45° field of view: 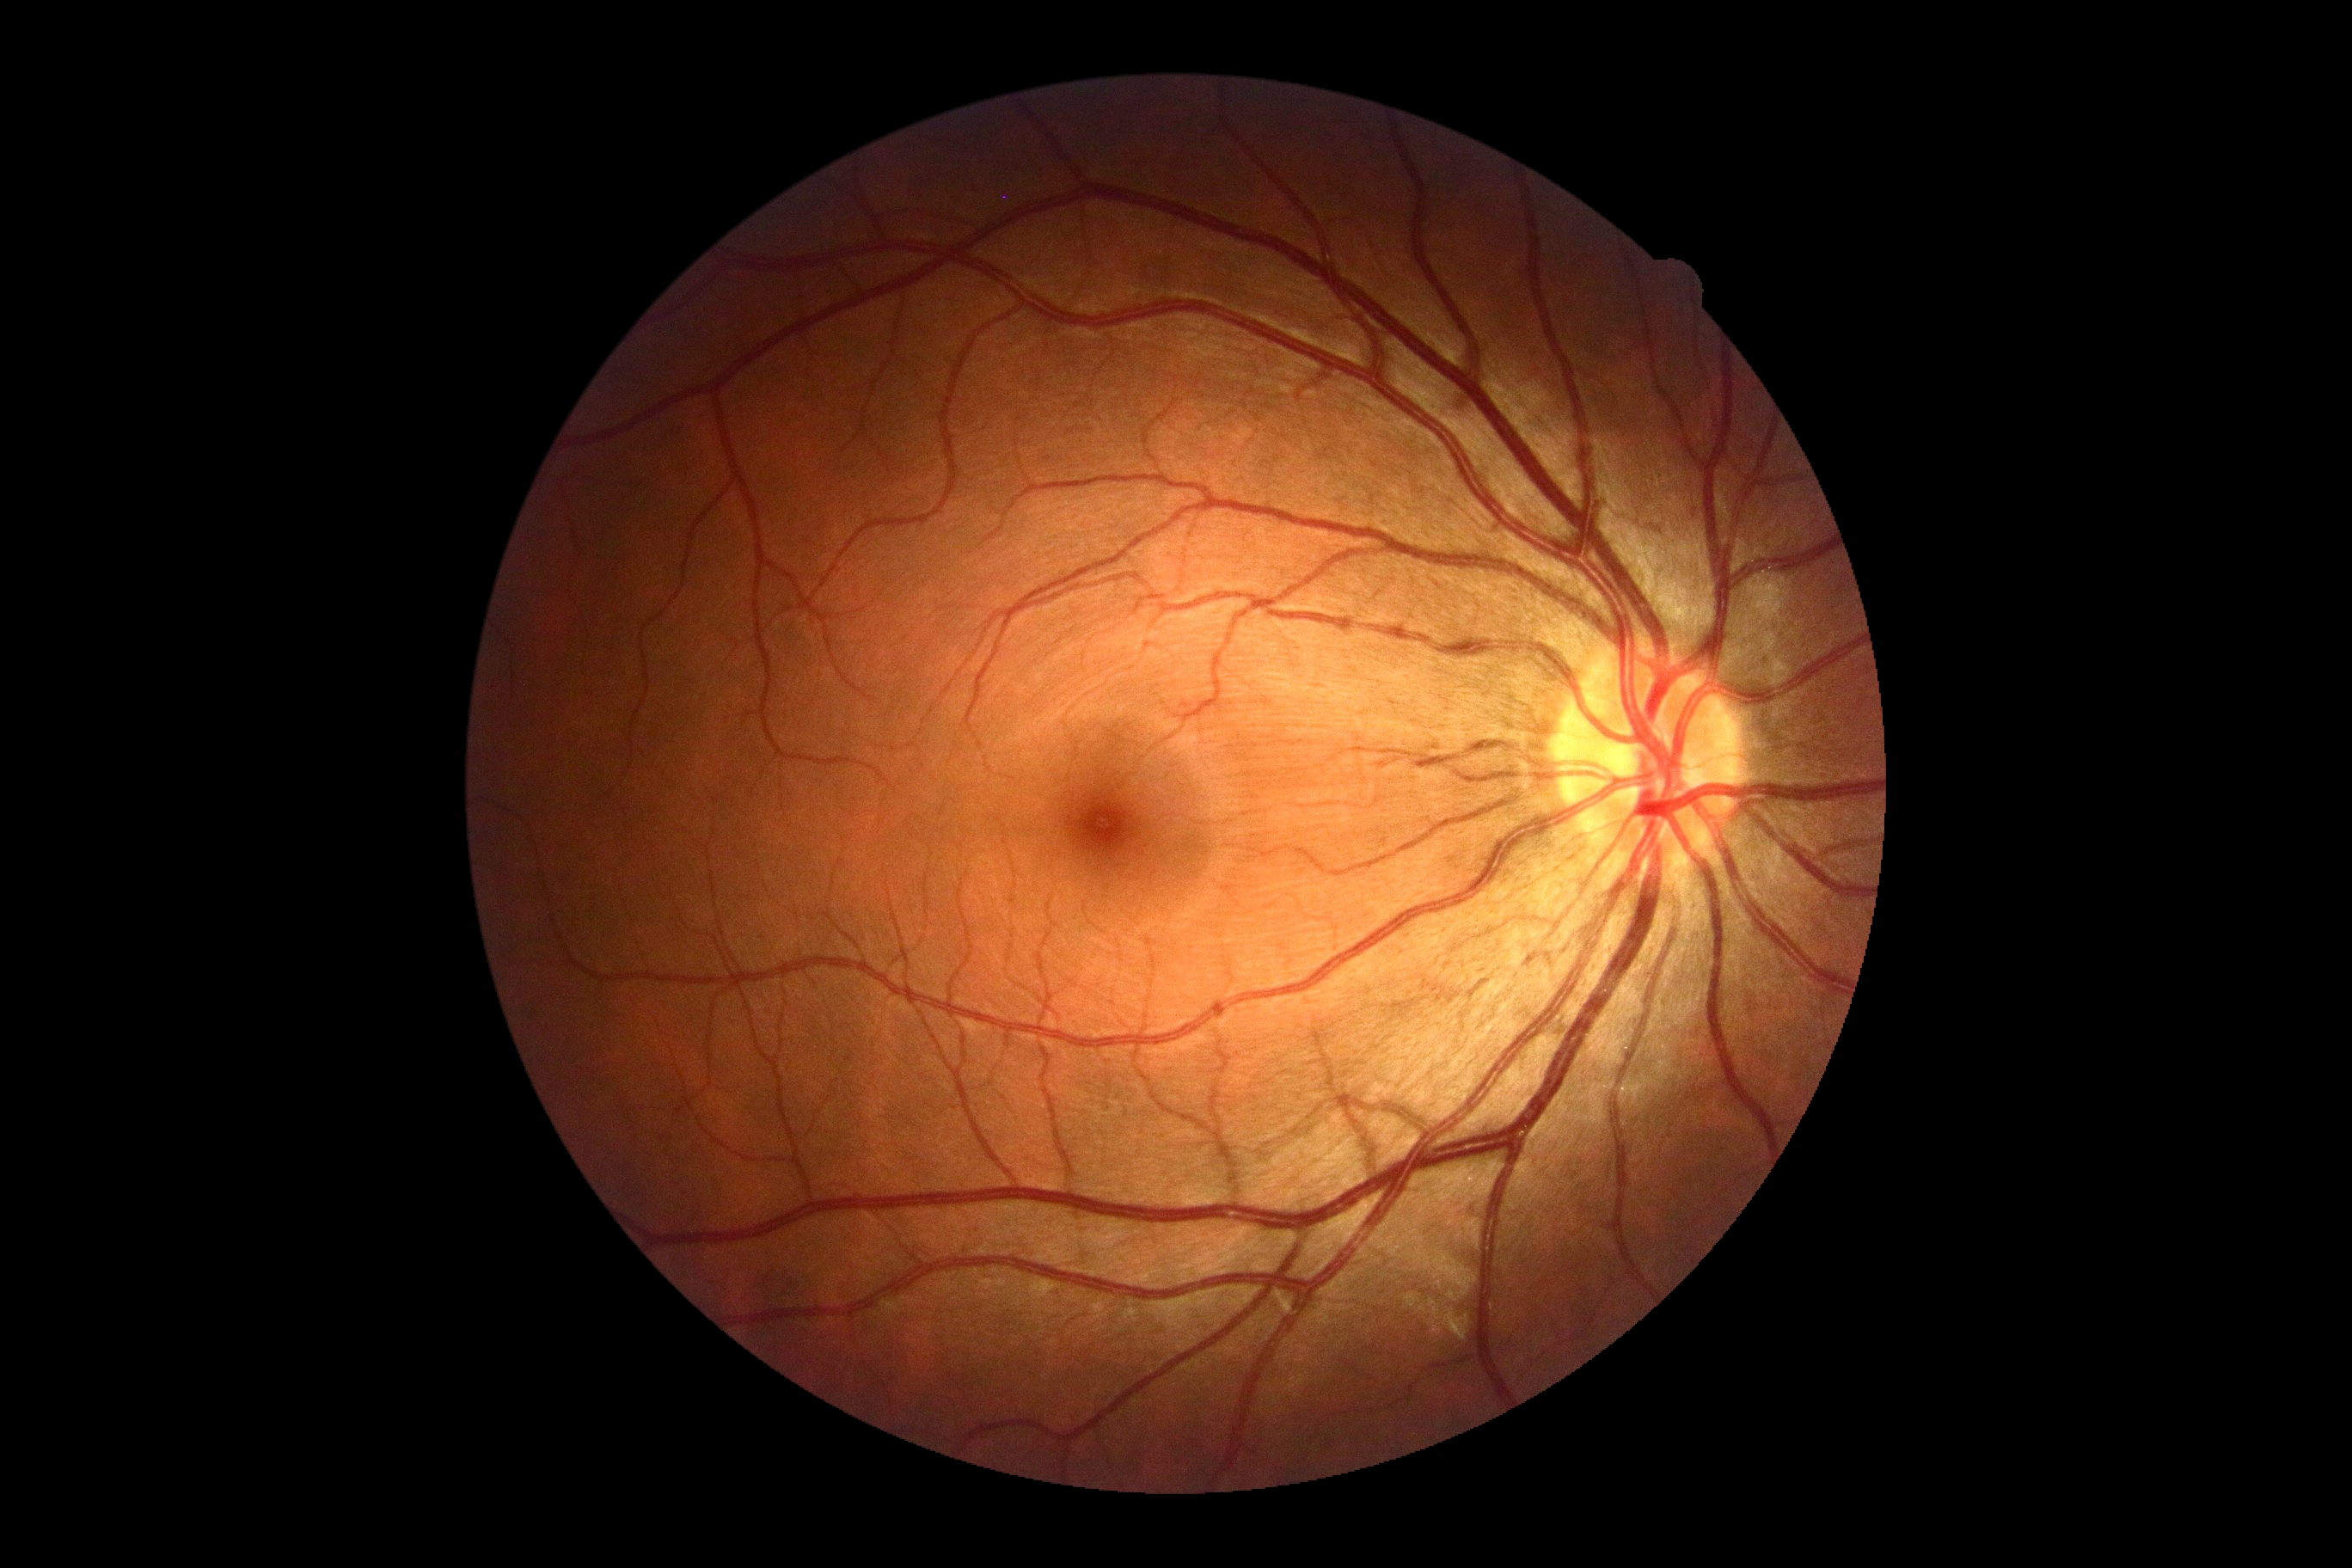
No DR findings.
DR stage is grade 0 (no apparent retinopathy).